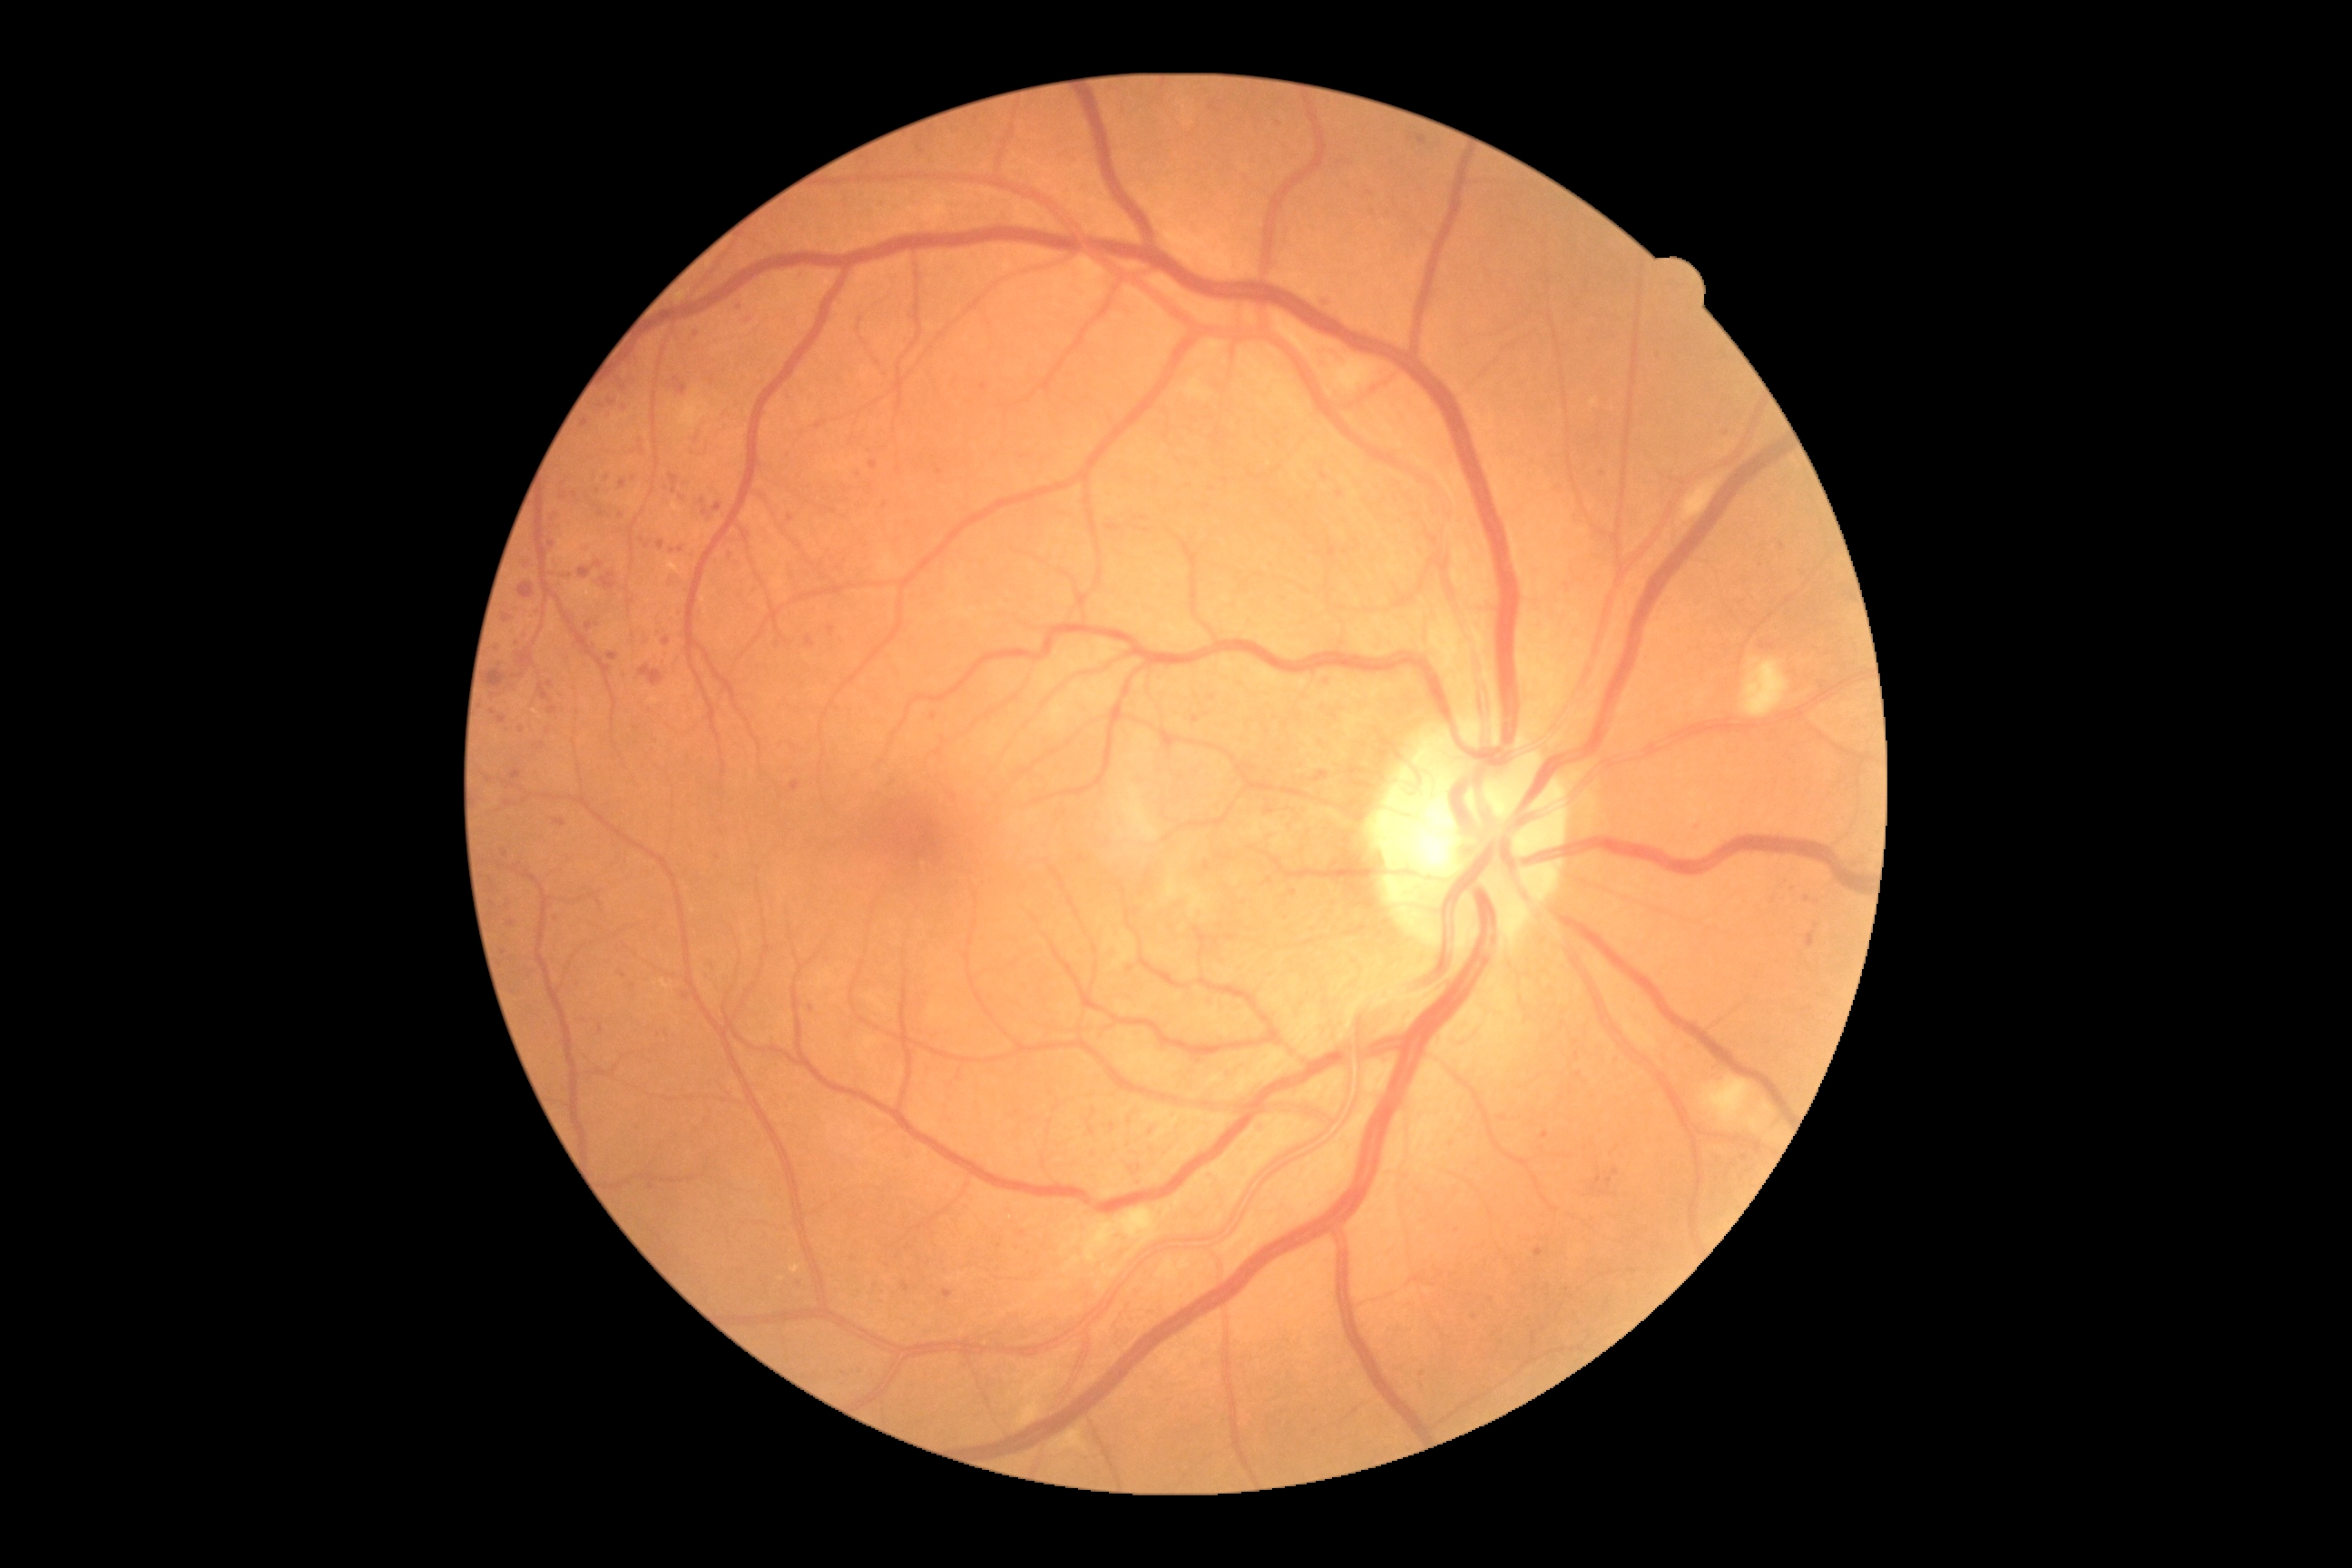
Diabetic retinopathy grade: moderate NPDR (2); non-proliferative diabetic retinopathy
A subset of detected lesions:
microaneurysms (subset): [1191,716,1200,723], [827,627,836,636], [680,382,689,393], [498,718,507,723], [1600,1191,1609,1197]
Small microaneurysms near <point>1475, 1317</point>, <point>584, 546</point>, <point>643, 540</point>, <point>641, 441</point>, <point>623, 975</point>, <point>1792, 887</point>, <point>1023, 1233</point>, <point>1291, 890</point>, <point>1579, 1075</point>, <point>1151, 1131</point>, <point>792, 519</point>, <point>612, 403</point>